Phoenix ICON, 100° FOV. Wide-field fundus photograph from neonatal ROP screening — 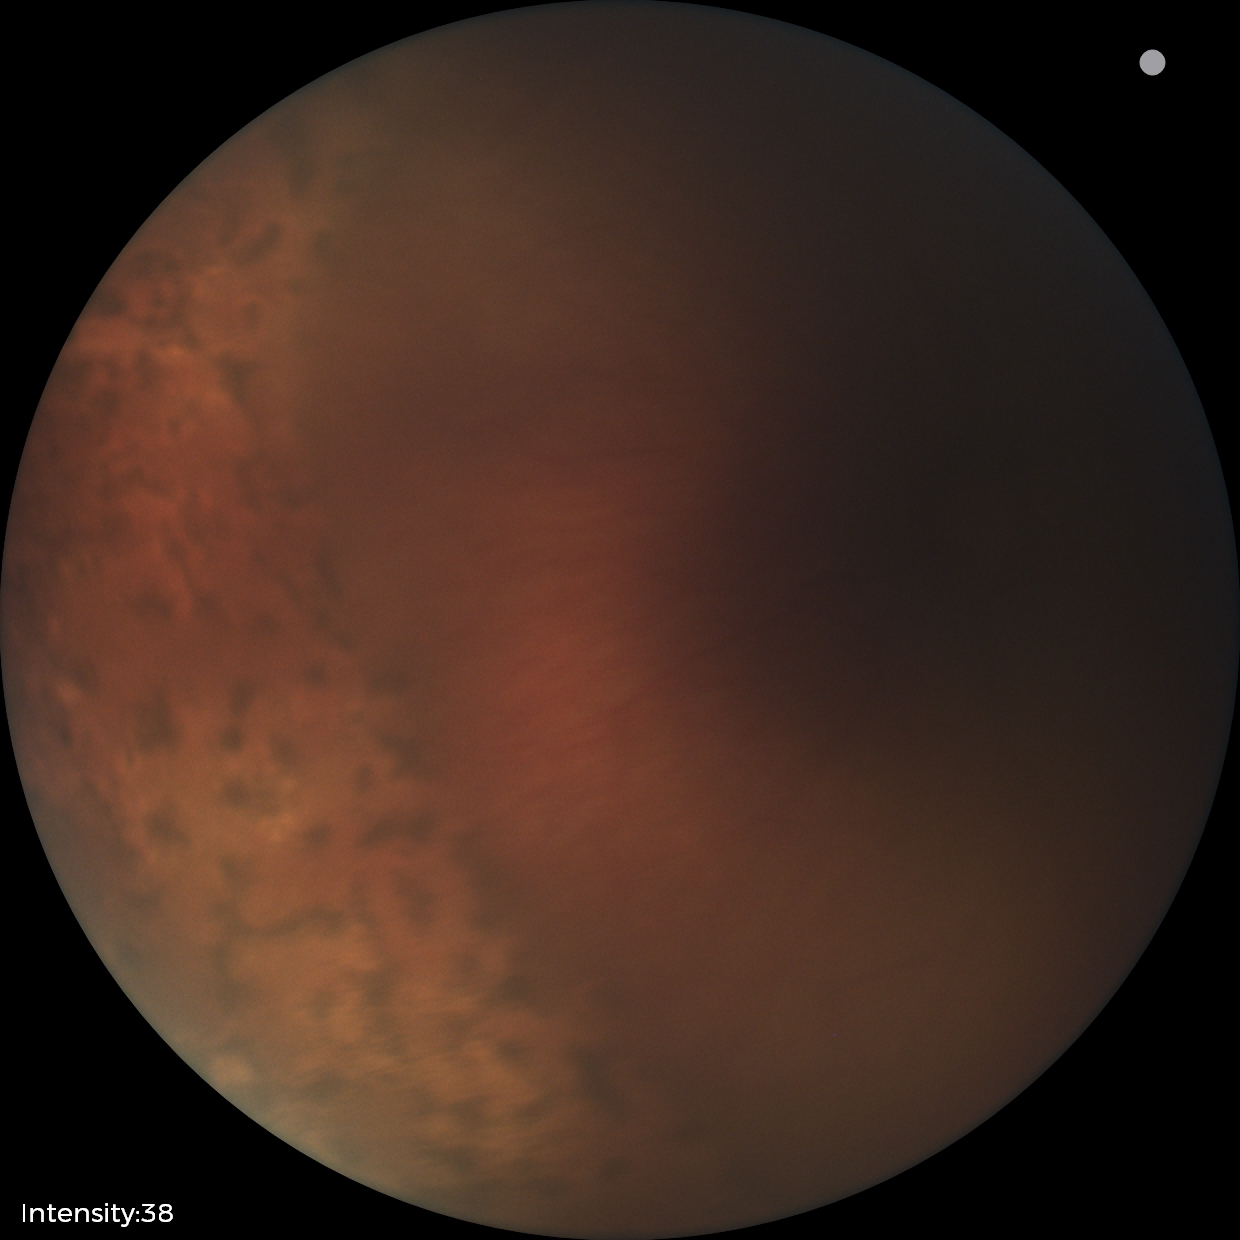 No plus disease. Screening examination consistent with status post ROP.